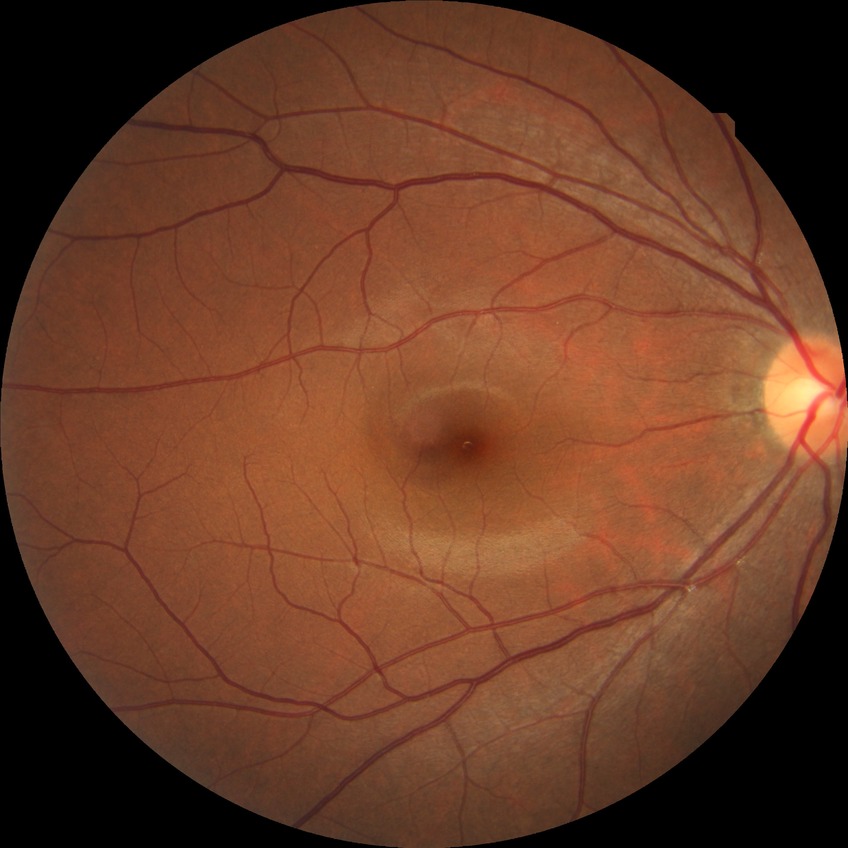
Modified Davis grade: NDR.